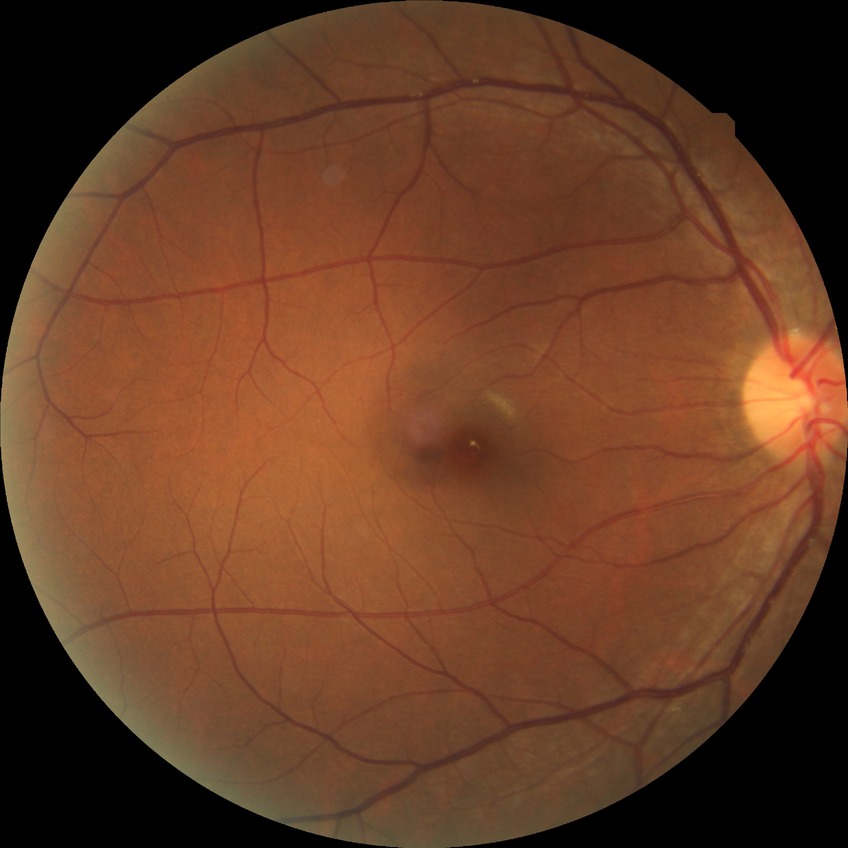

Findings:
– modified Davis classification — simple diabetic retinopathy